Ultra-widefield fundus photograph. 1924x1556:
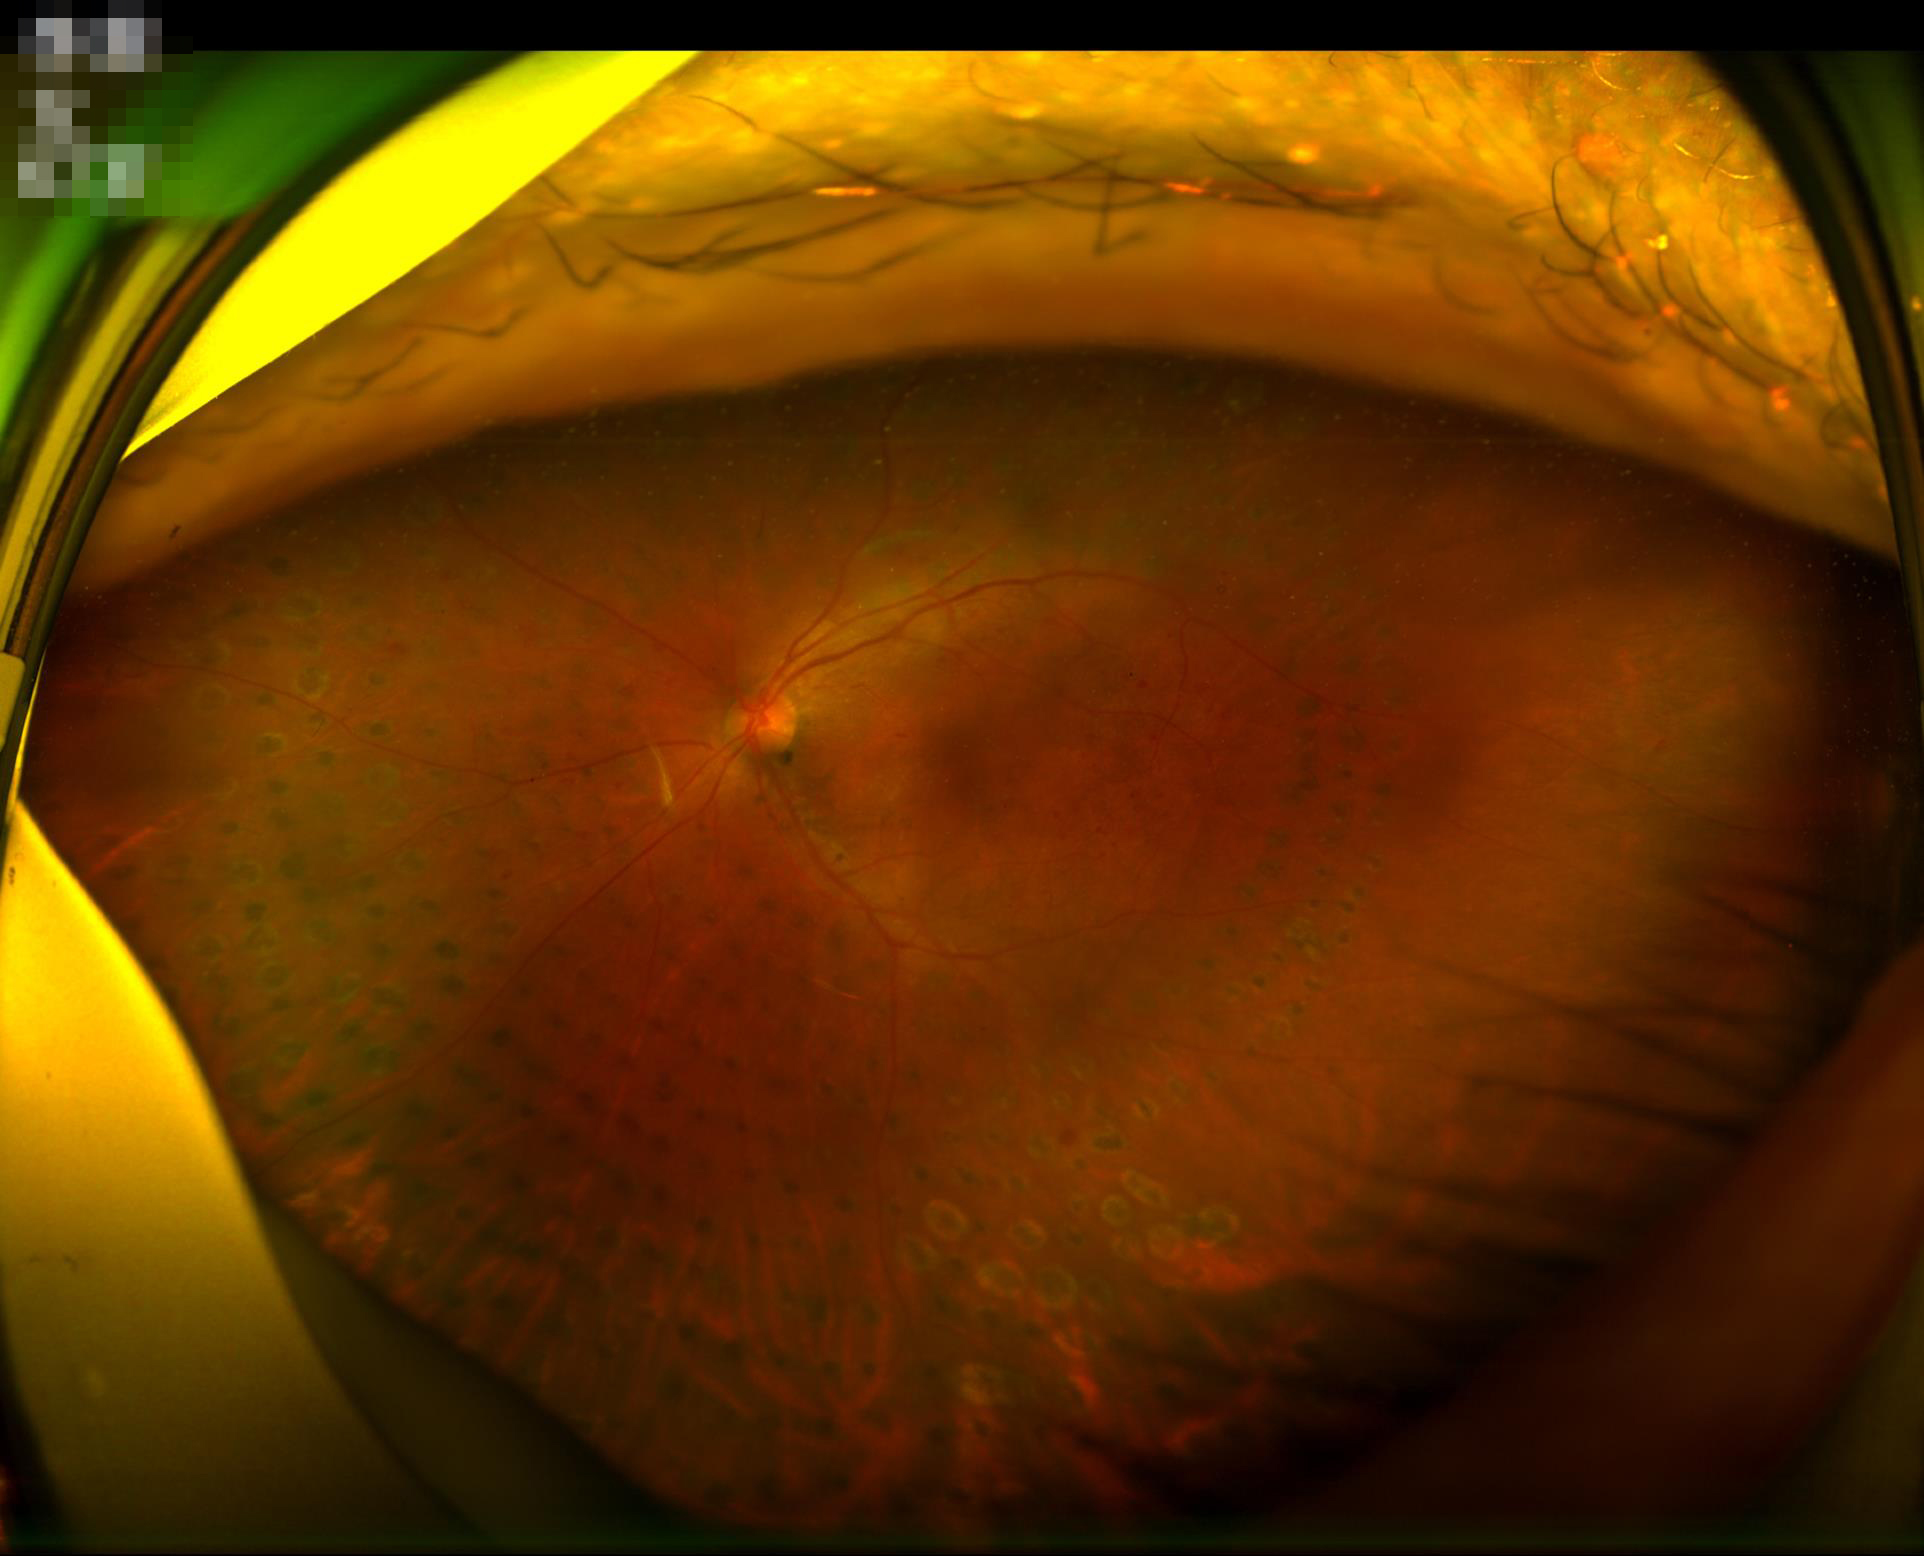
Contrast is good. There is over- or under-exposure or a color cast. Image quality is adequate for diagnostic use. No noticeable blur.